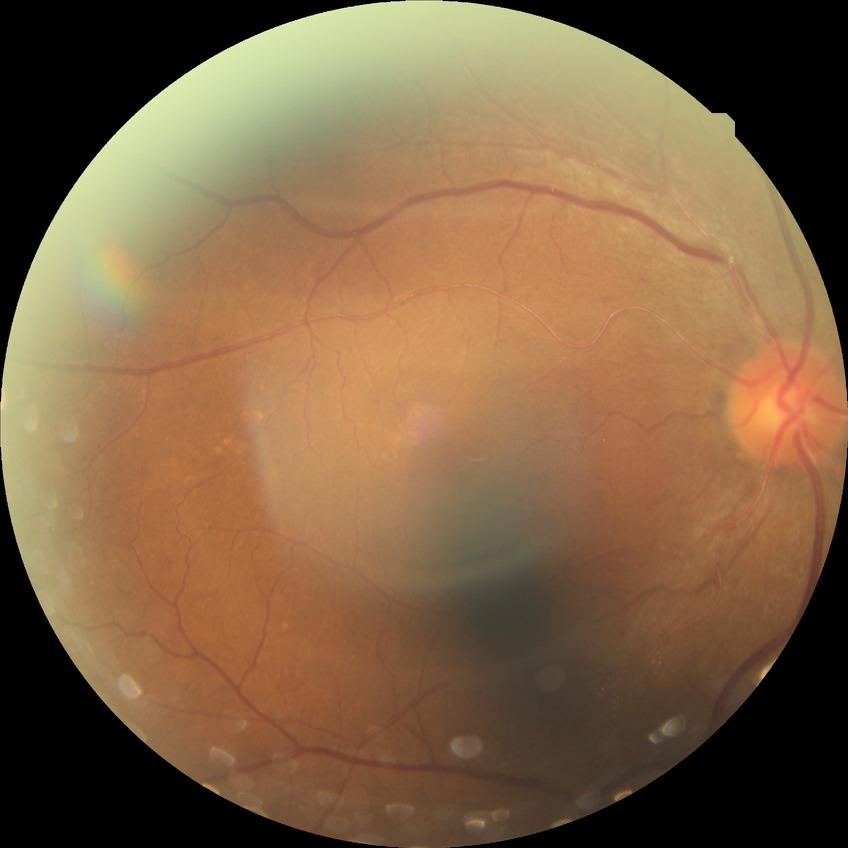 retinopathy grade = no diabetic retinopathy.